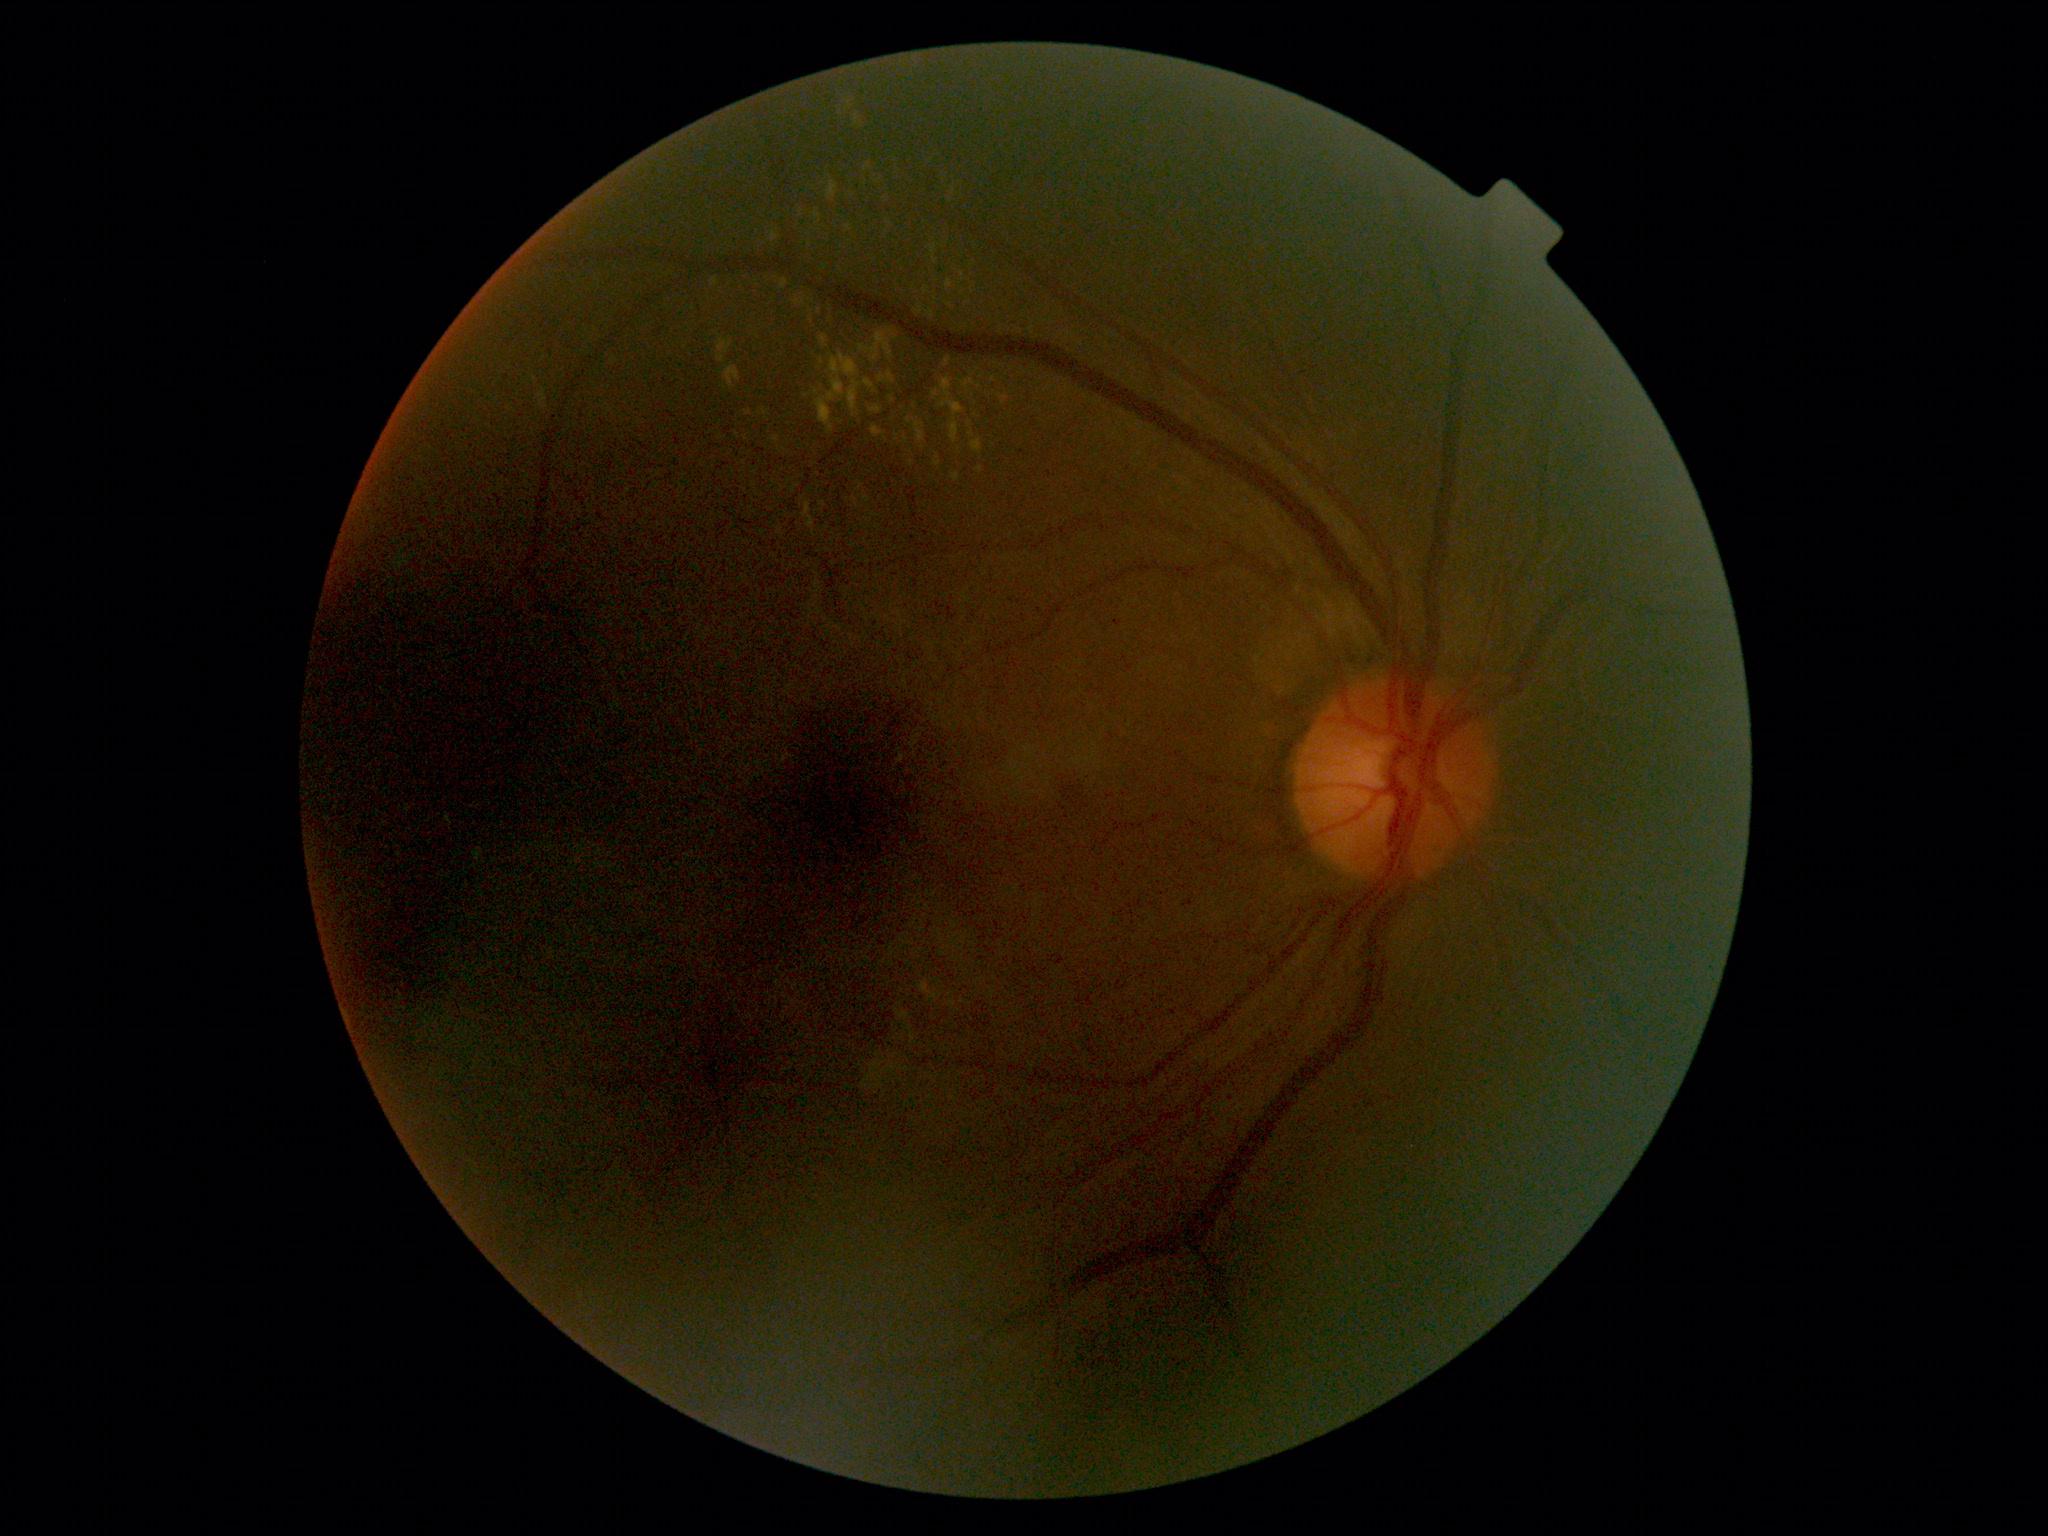

{"dr_grade": "grade 2"}